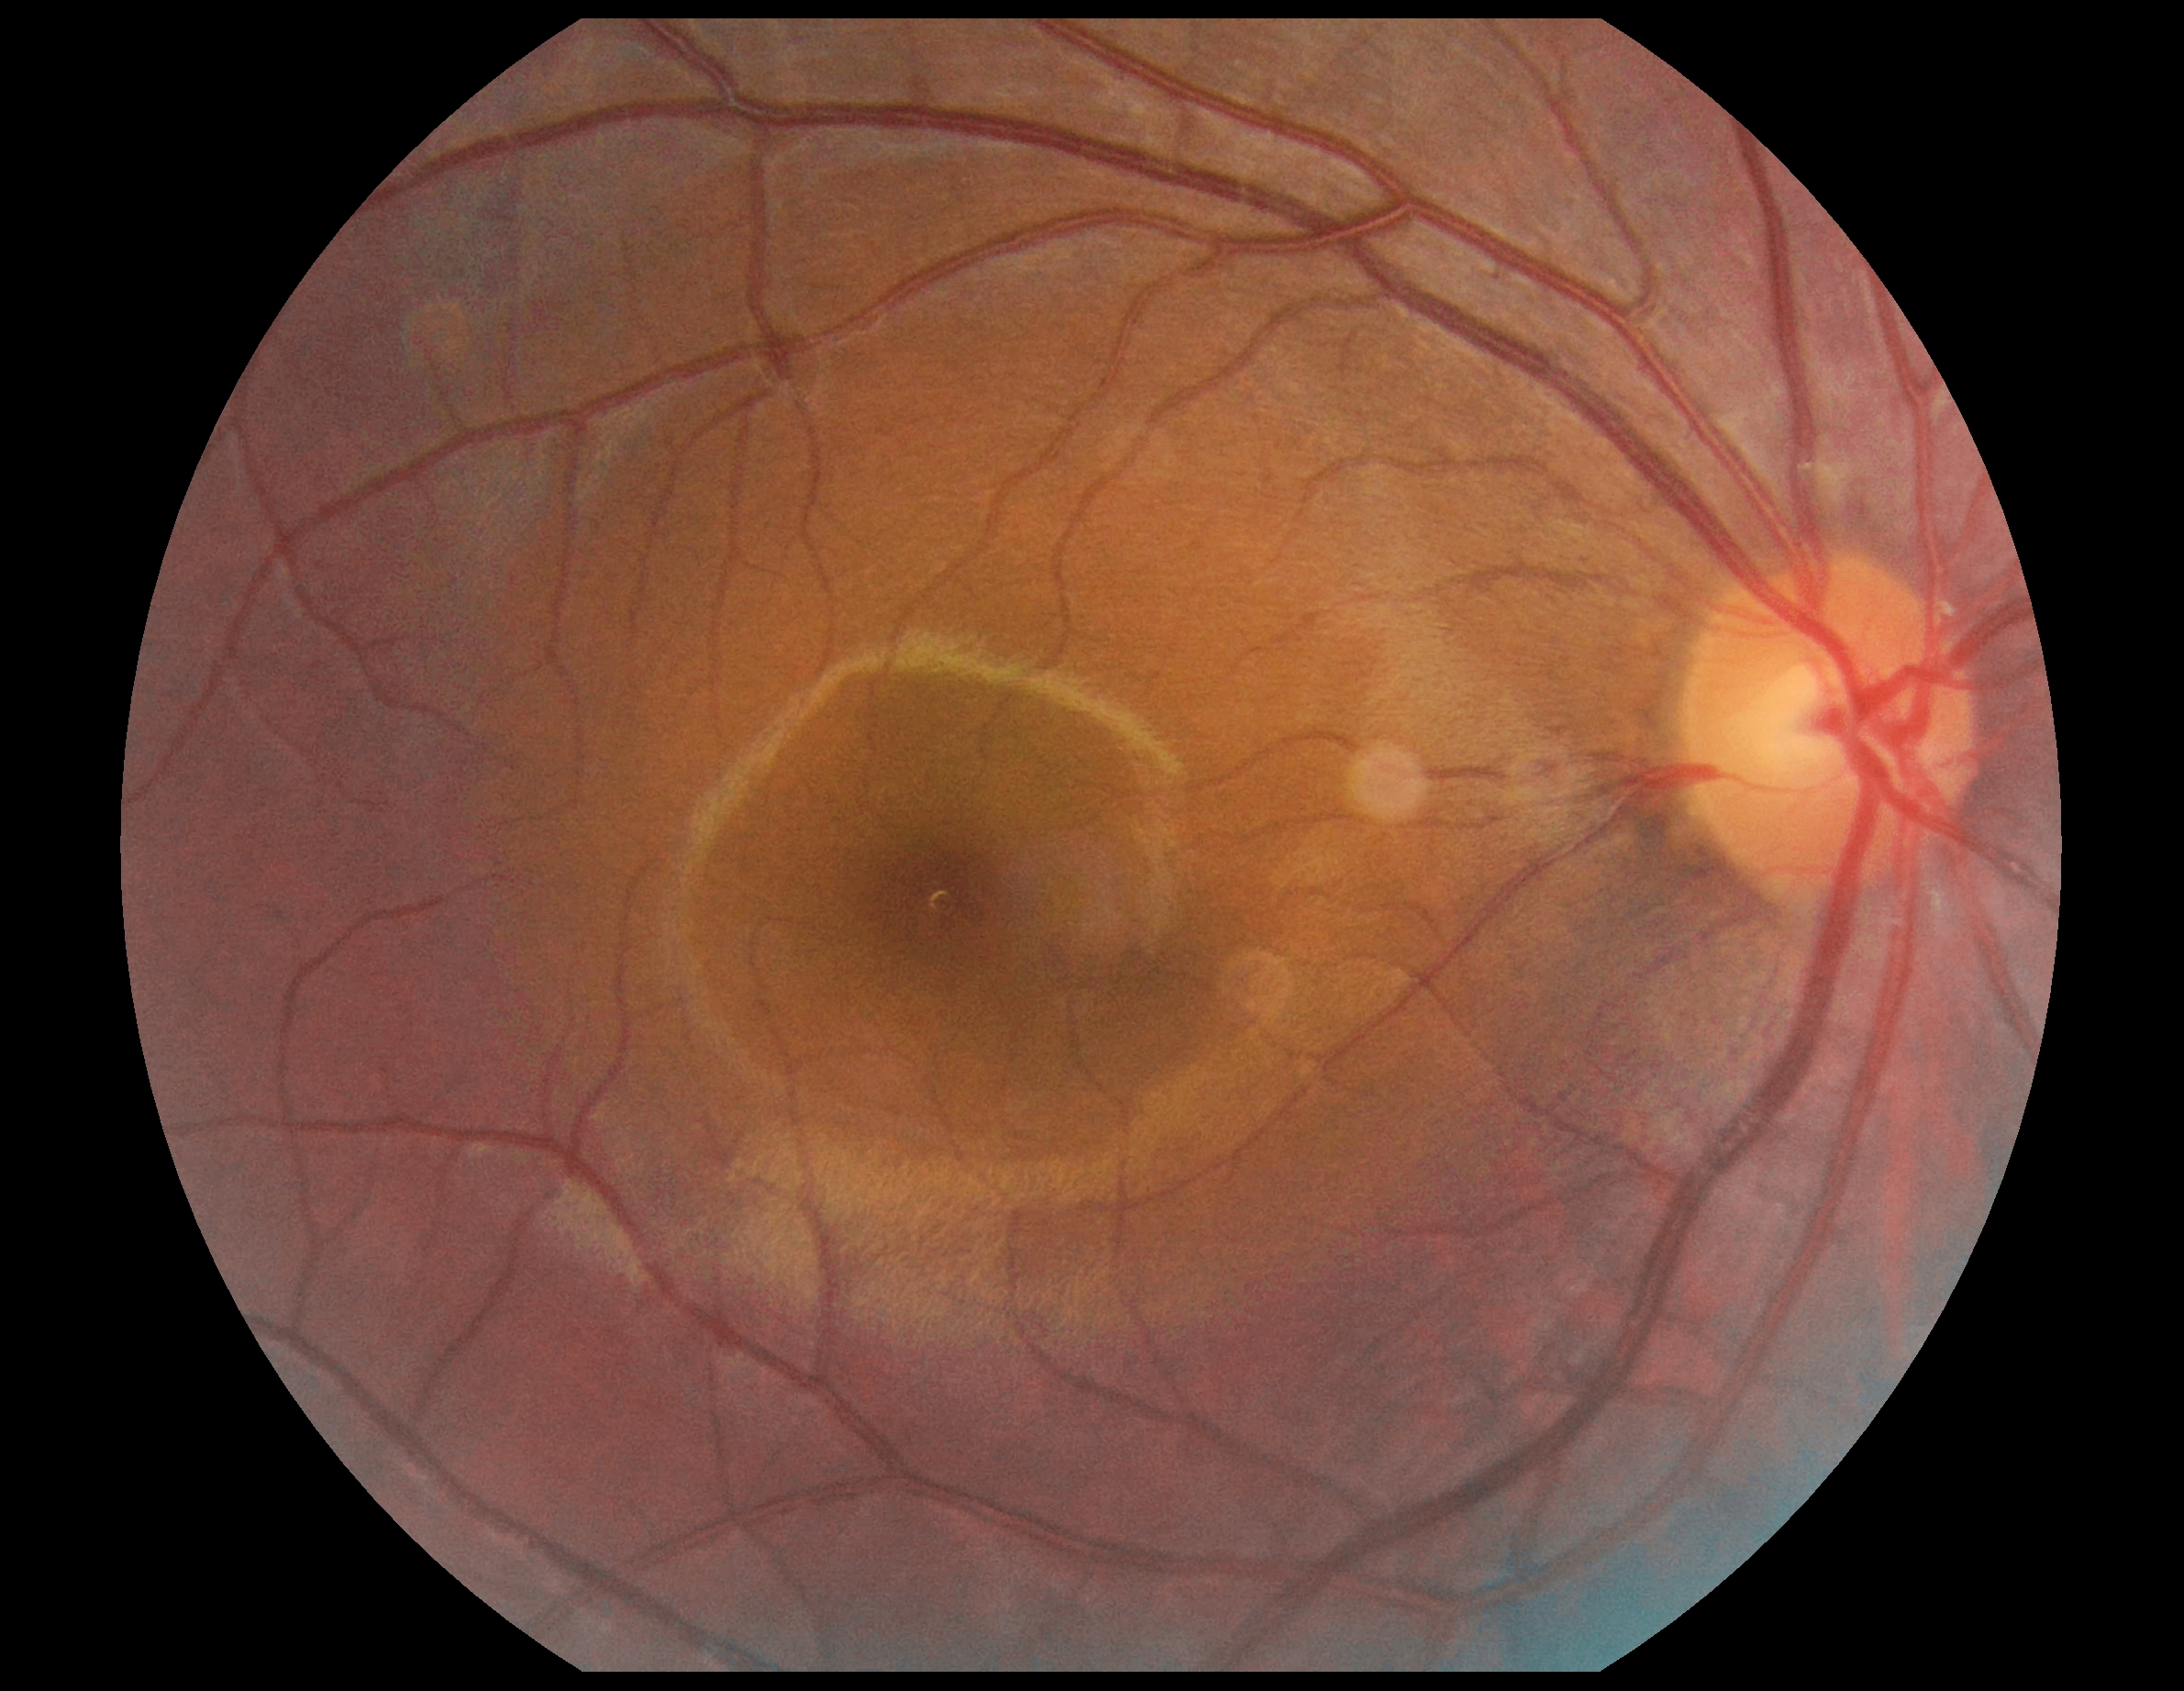 DR severity: no apparent diabetic retinopathy (grade 0).
No diabetic retinal disease findings.